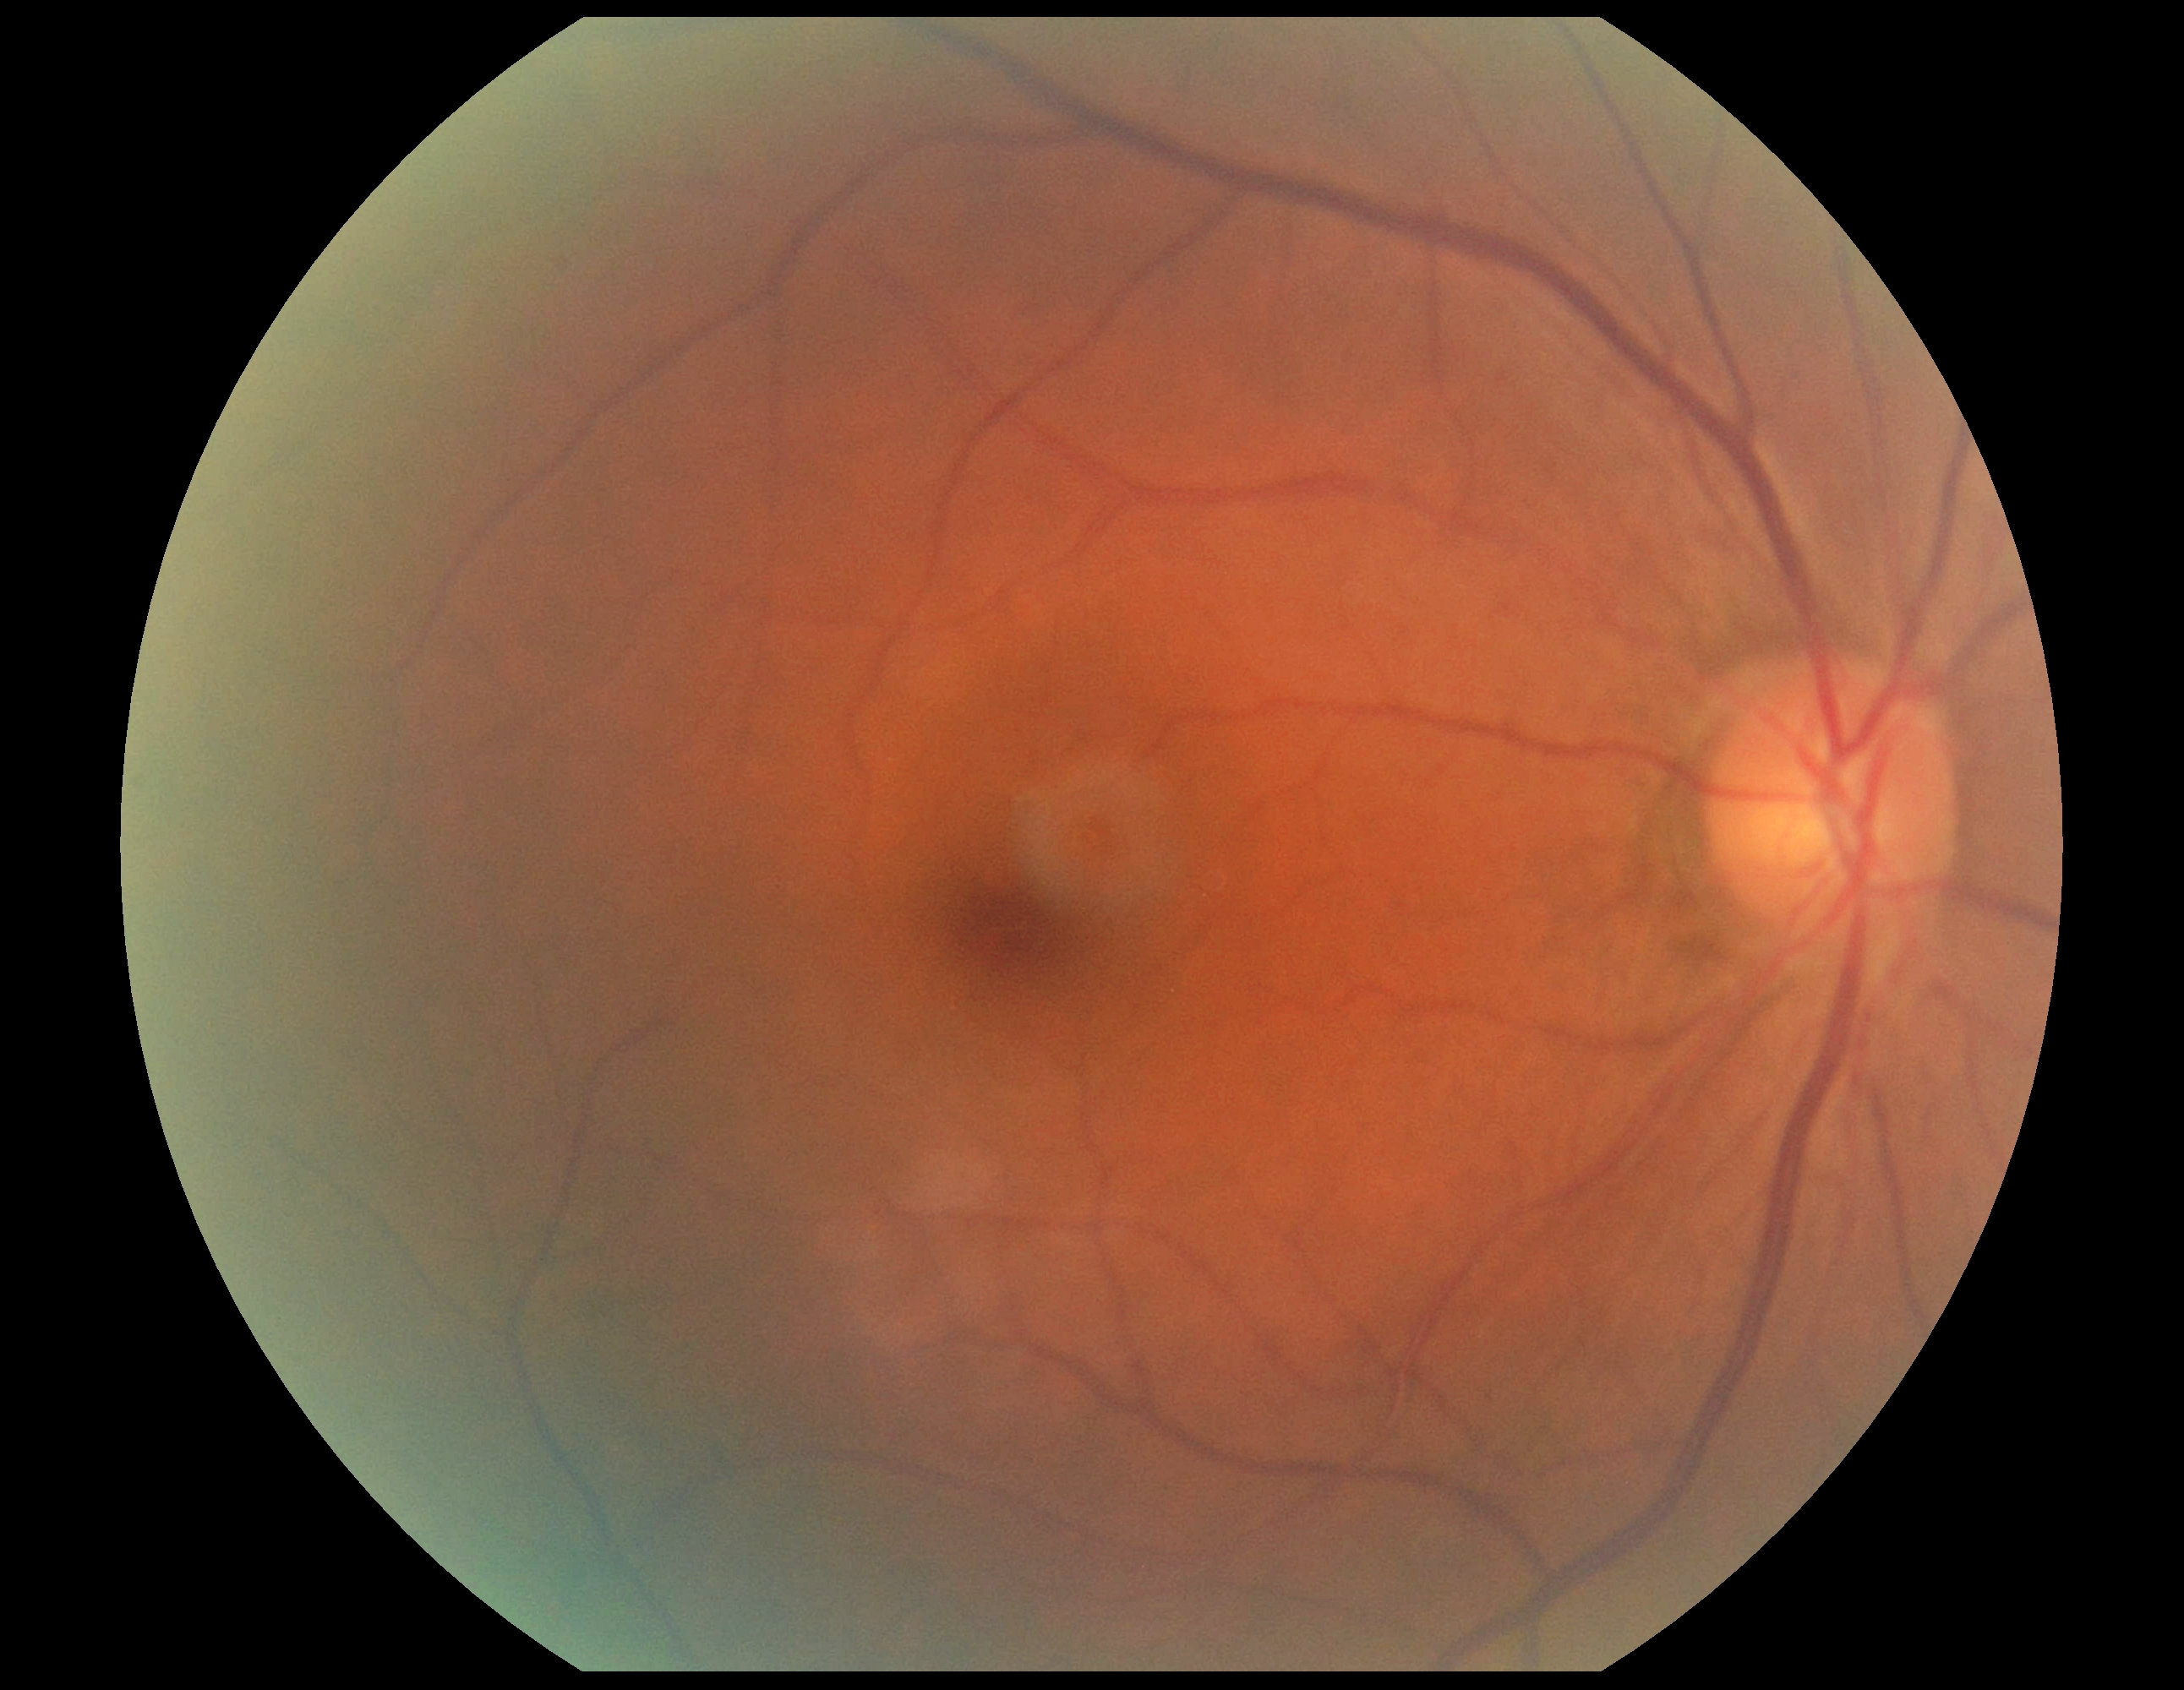

Findings:
• DR stage — grade 0 (no apparent retinopathy) — no visible signs of diabetic retinopathy